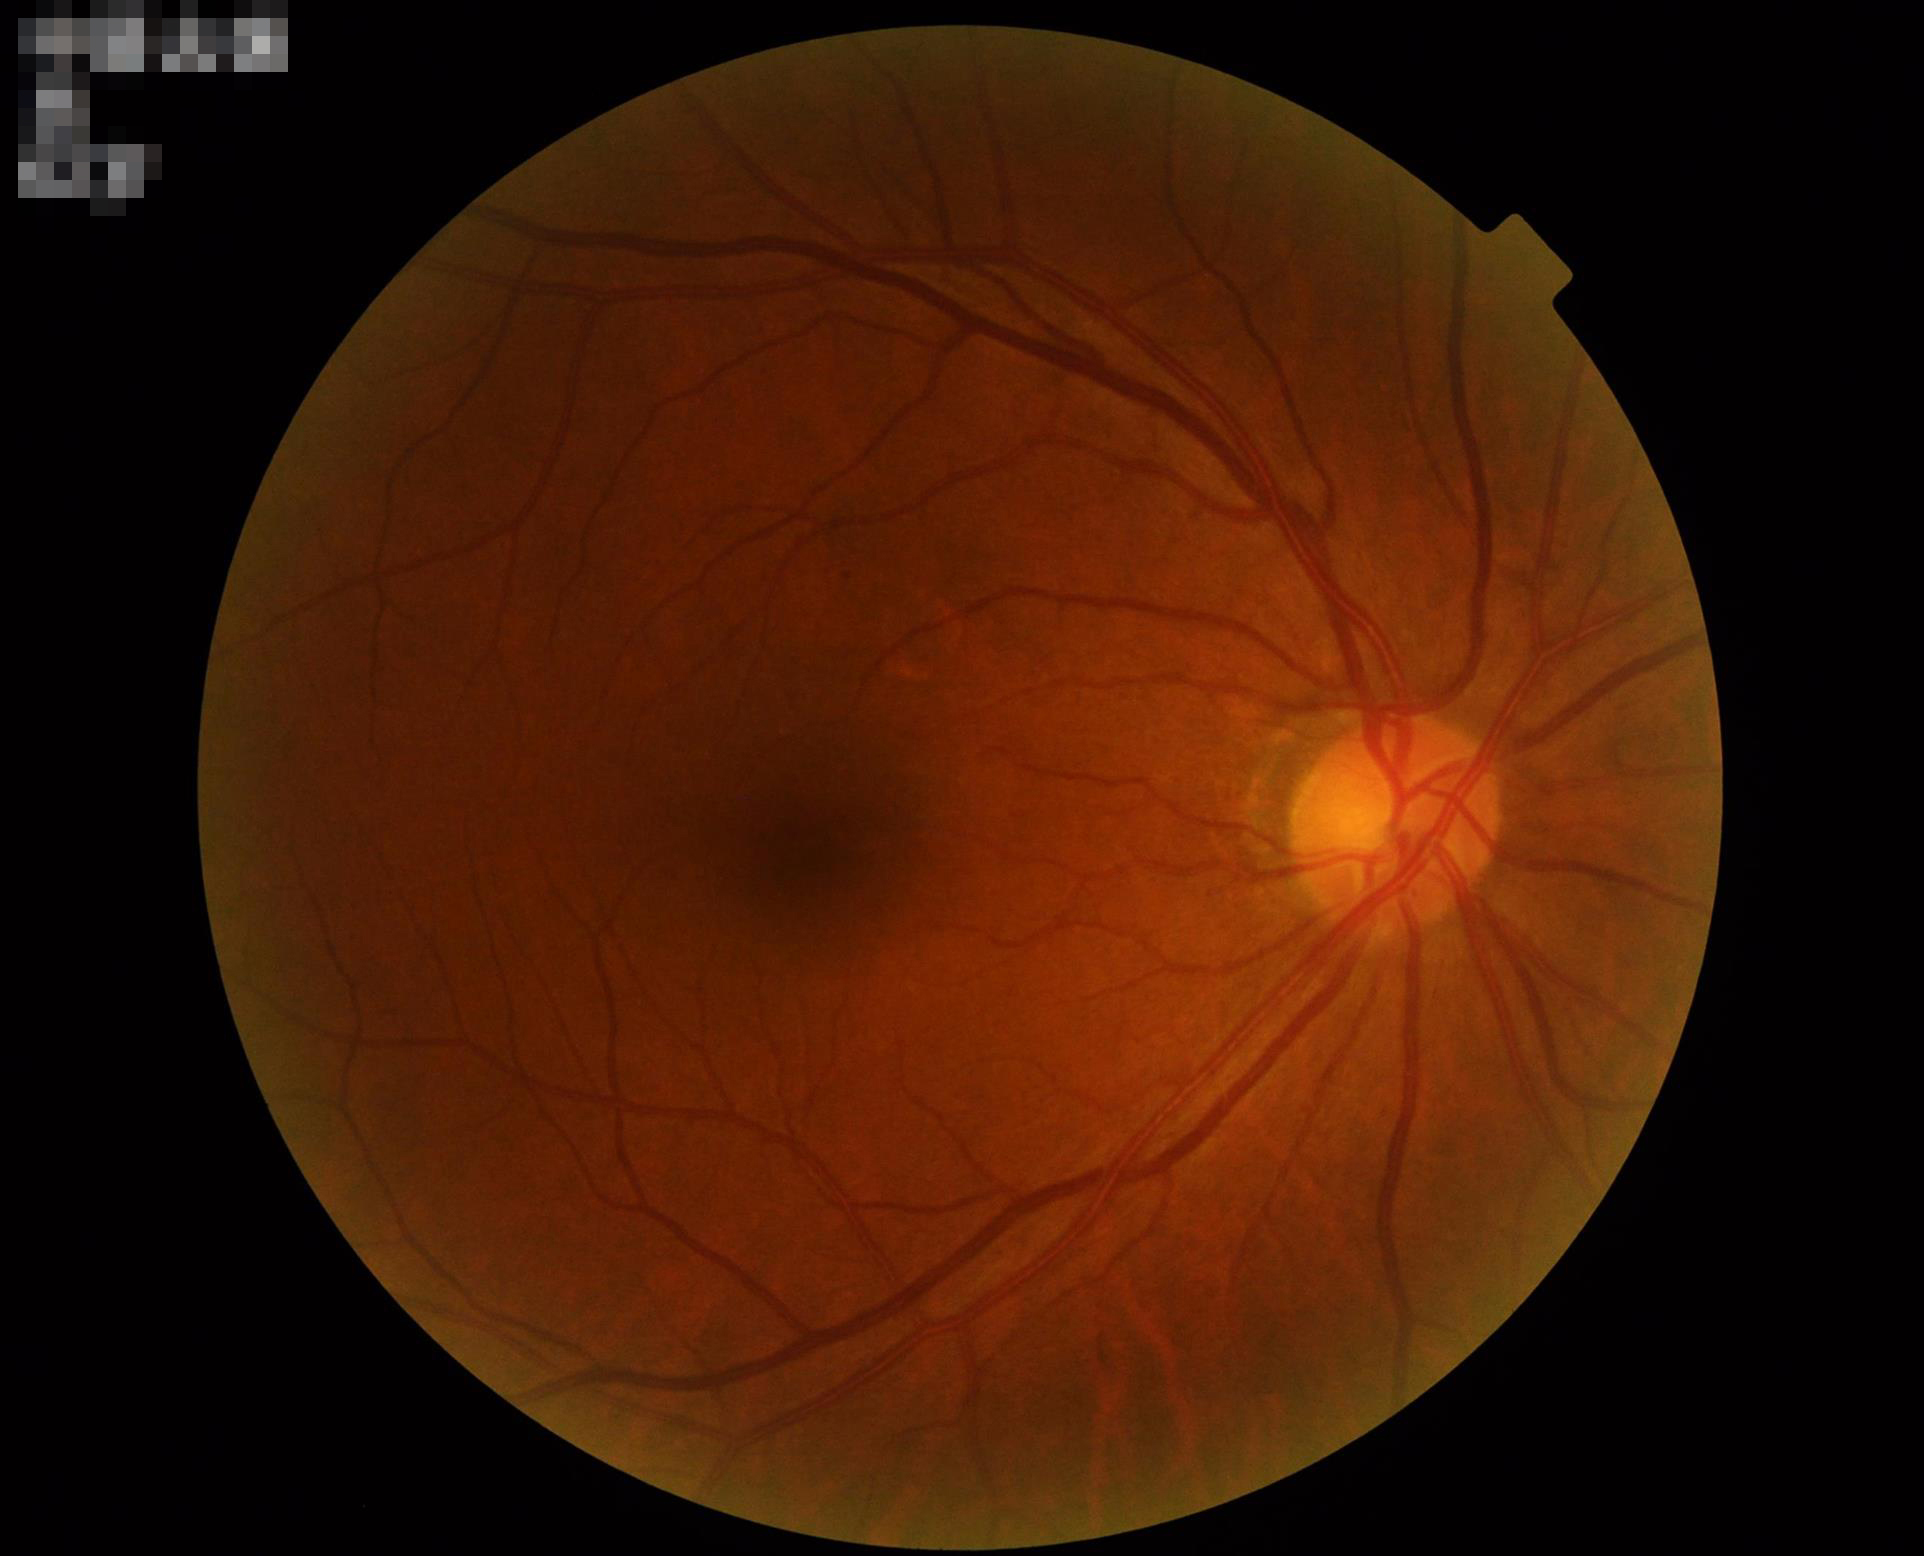 Quality assessment:
- contrast: adequate
- focus: sharp
- illumination/color: good
- overall: good